1960 by 1897 pixels. Color fundus image. 45° FOV:
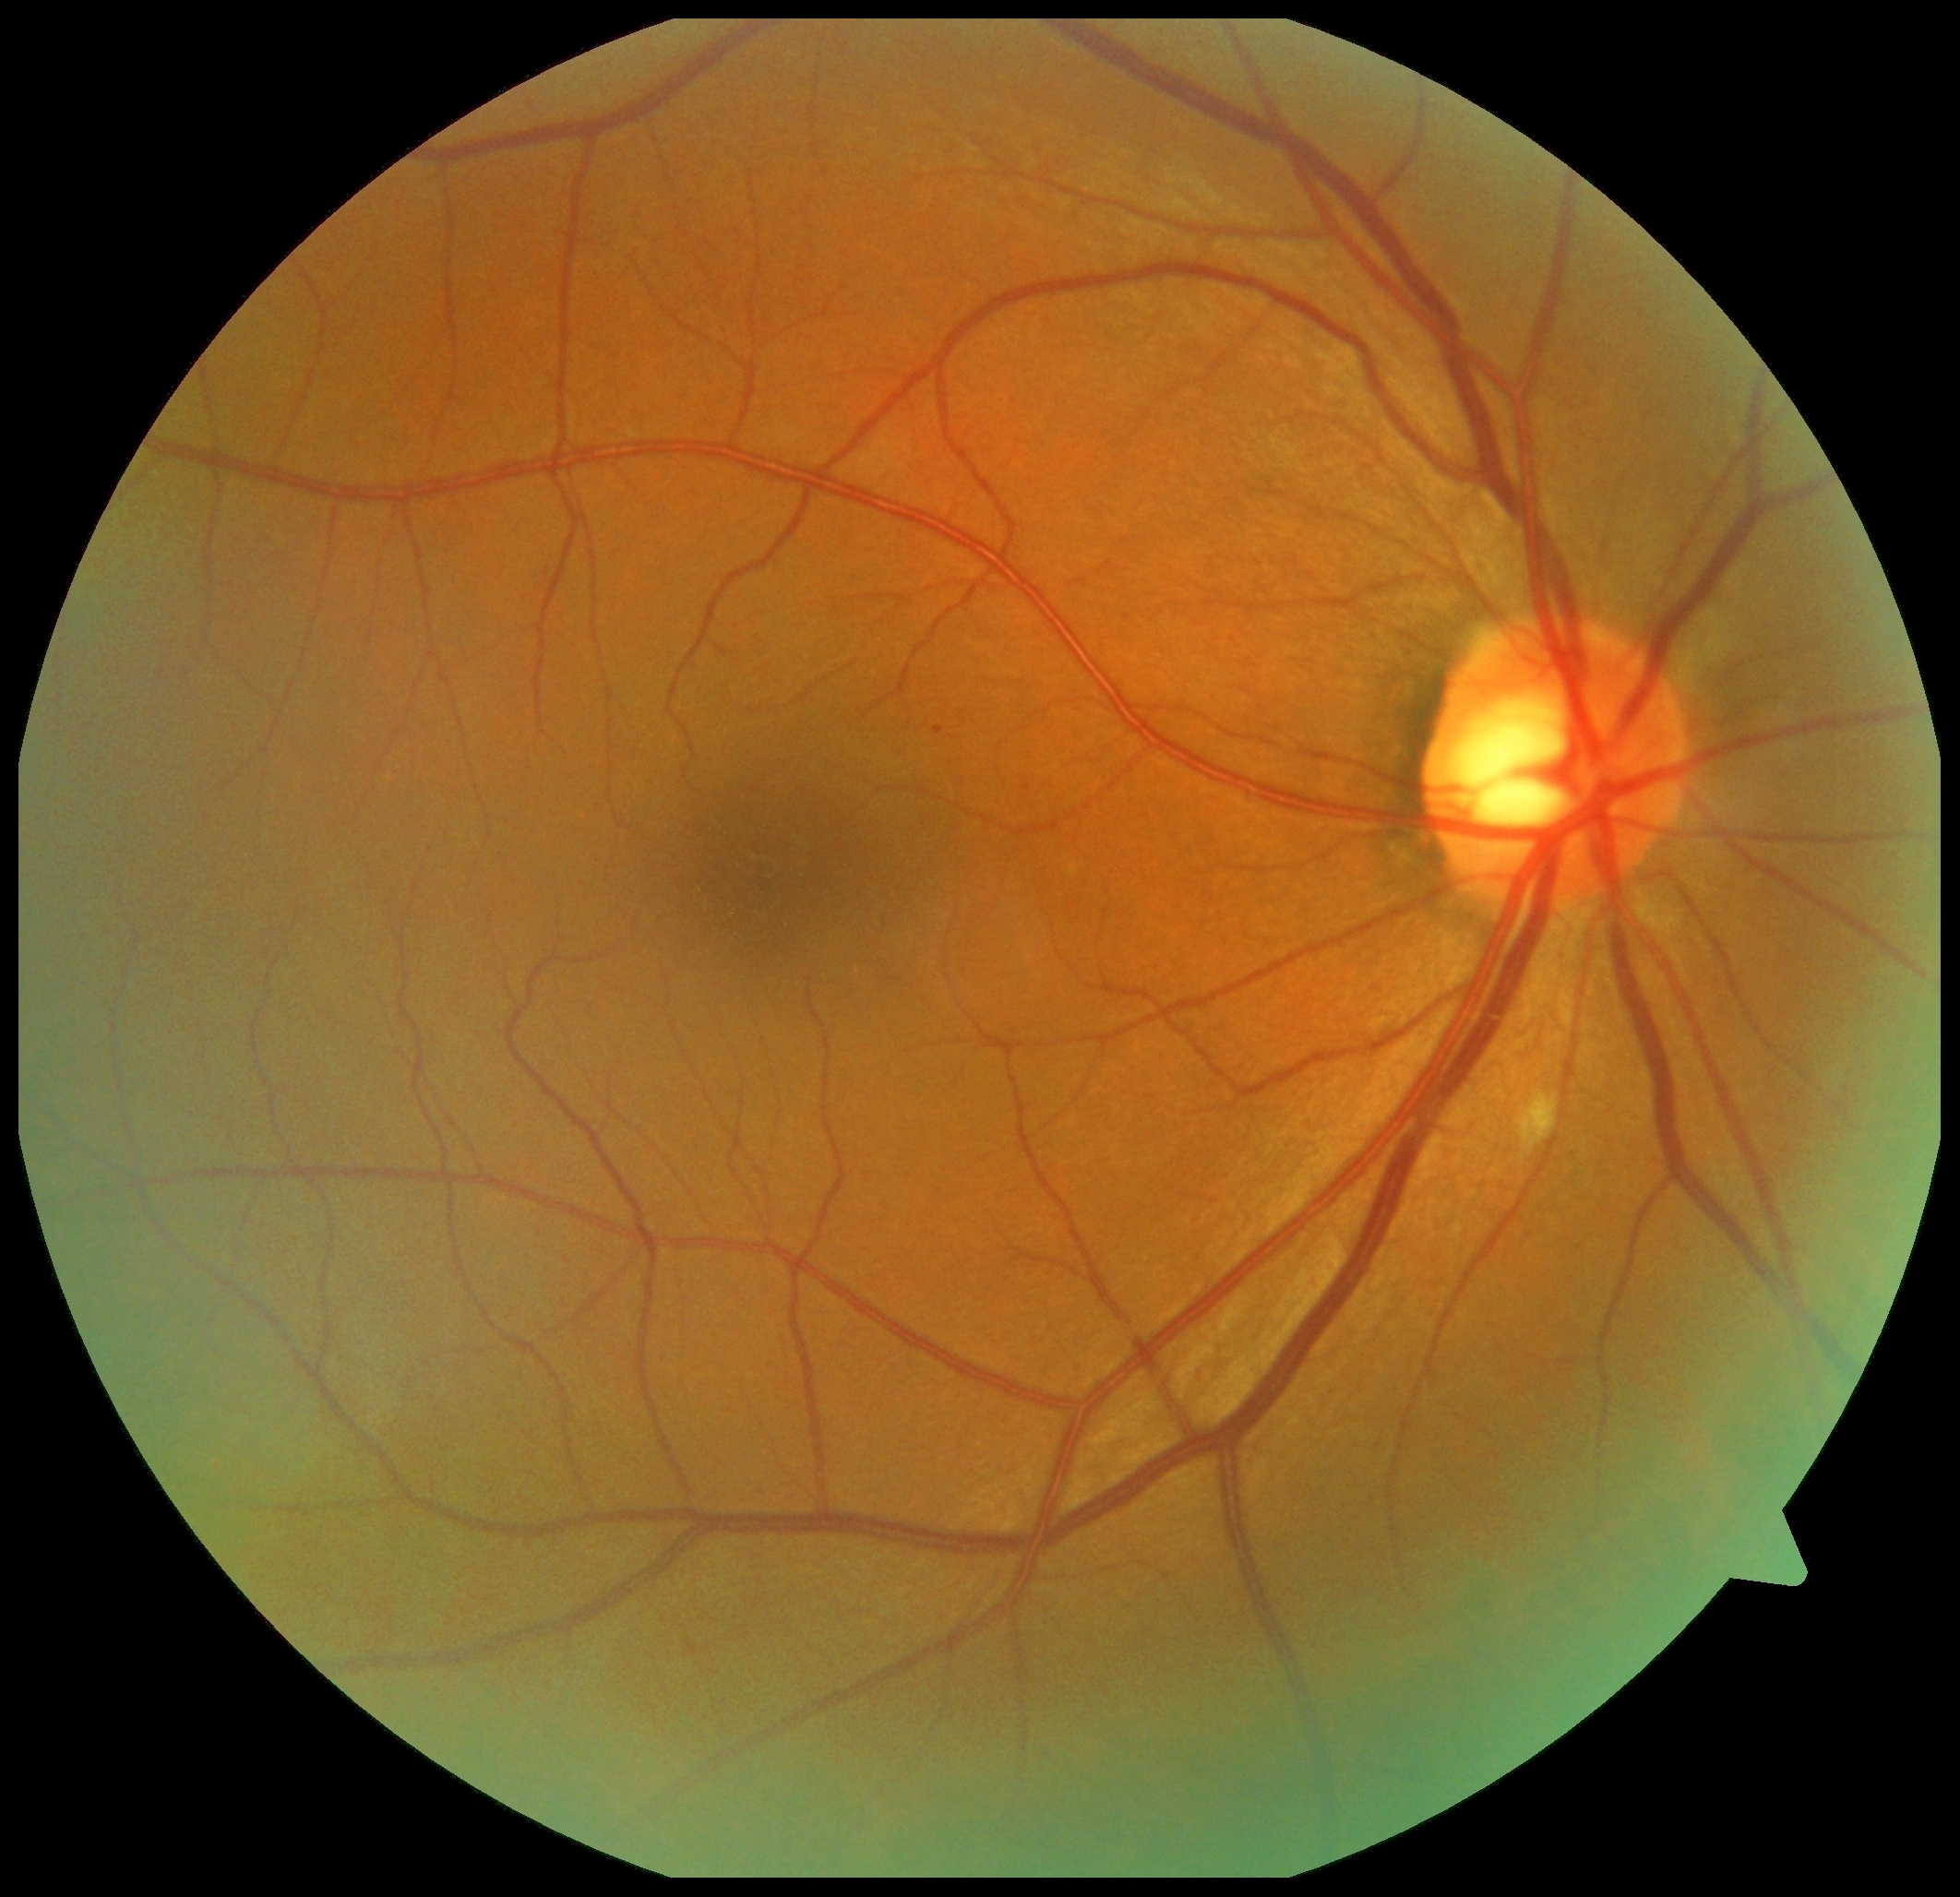

diabetic retinopathy = 2
DR class = non-proliferative diabetic retinopathy